Infant wide-field fundus photograph; camera: Natus RetCam Envision (130° FOV).
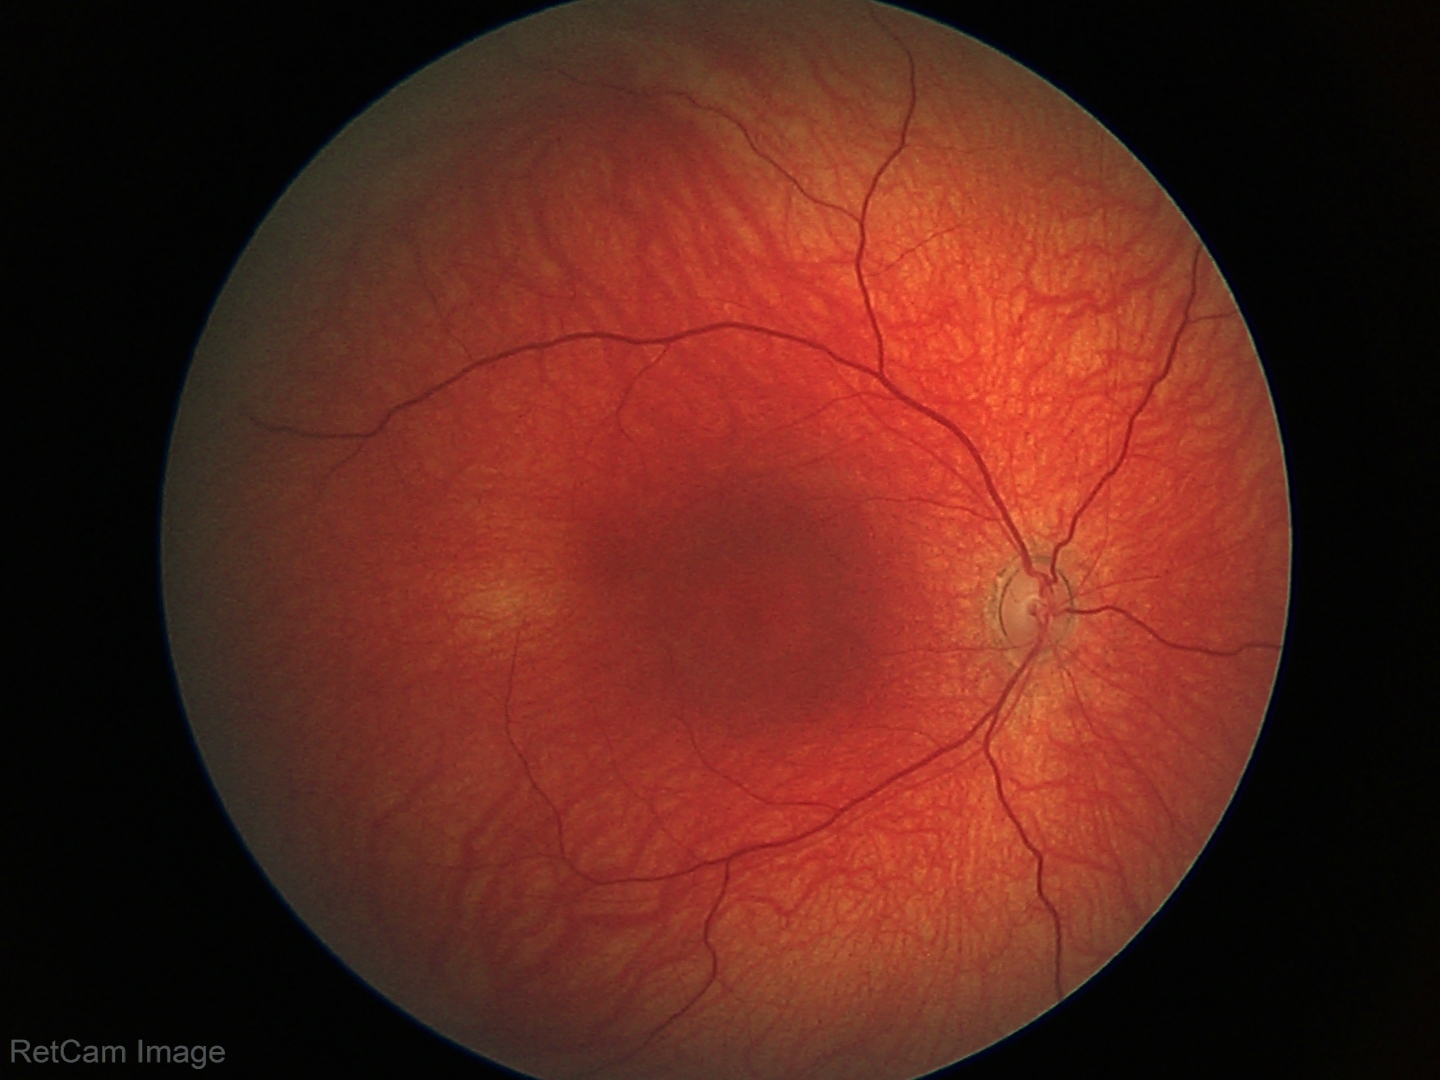 Examination with physiological retinal findings.